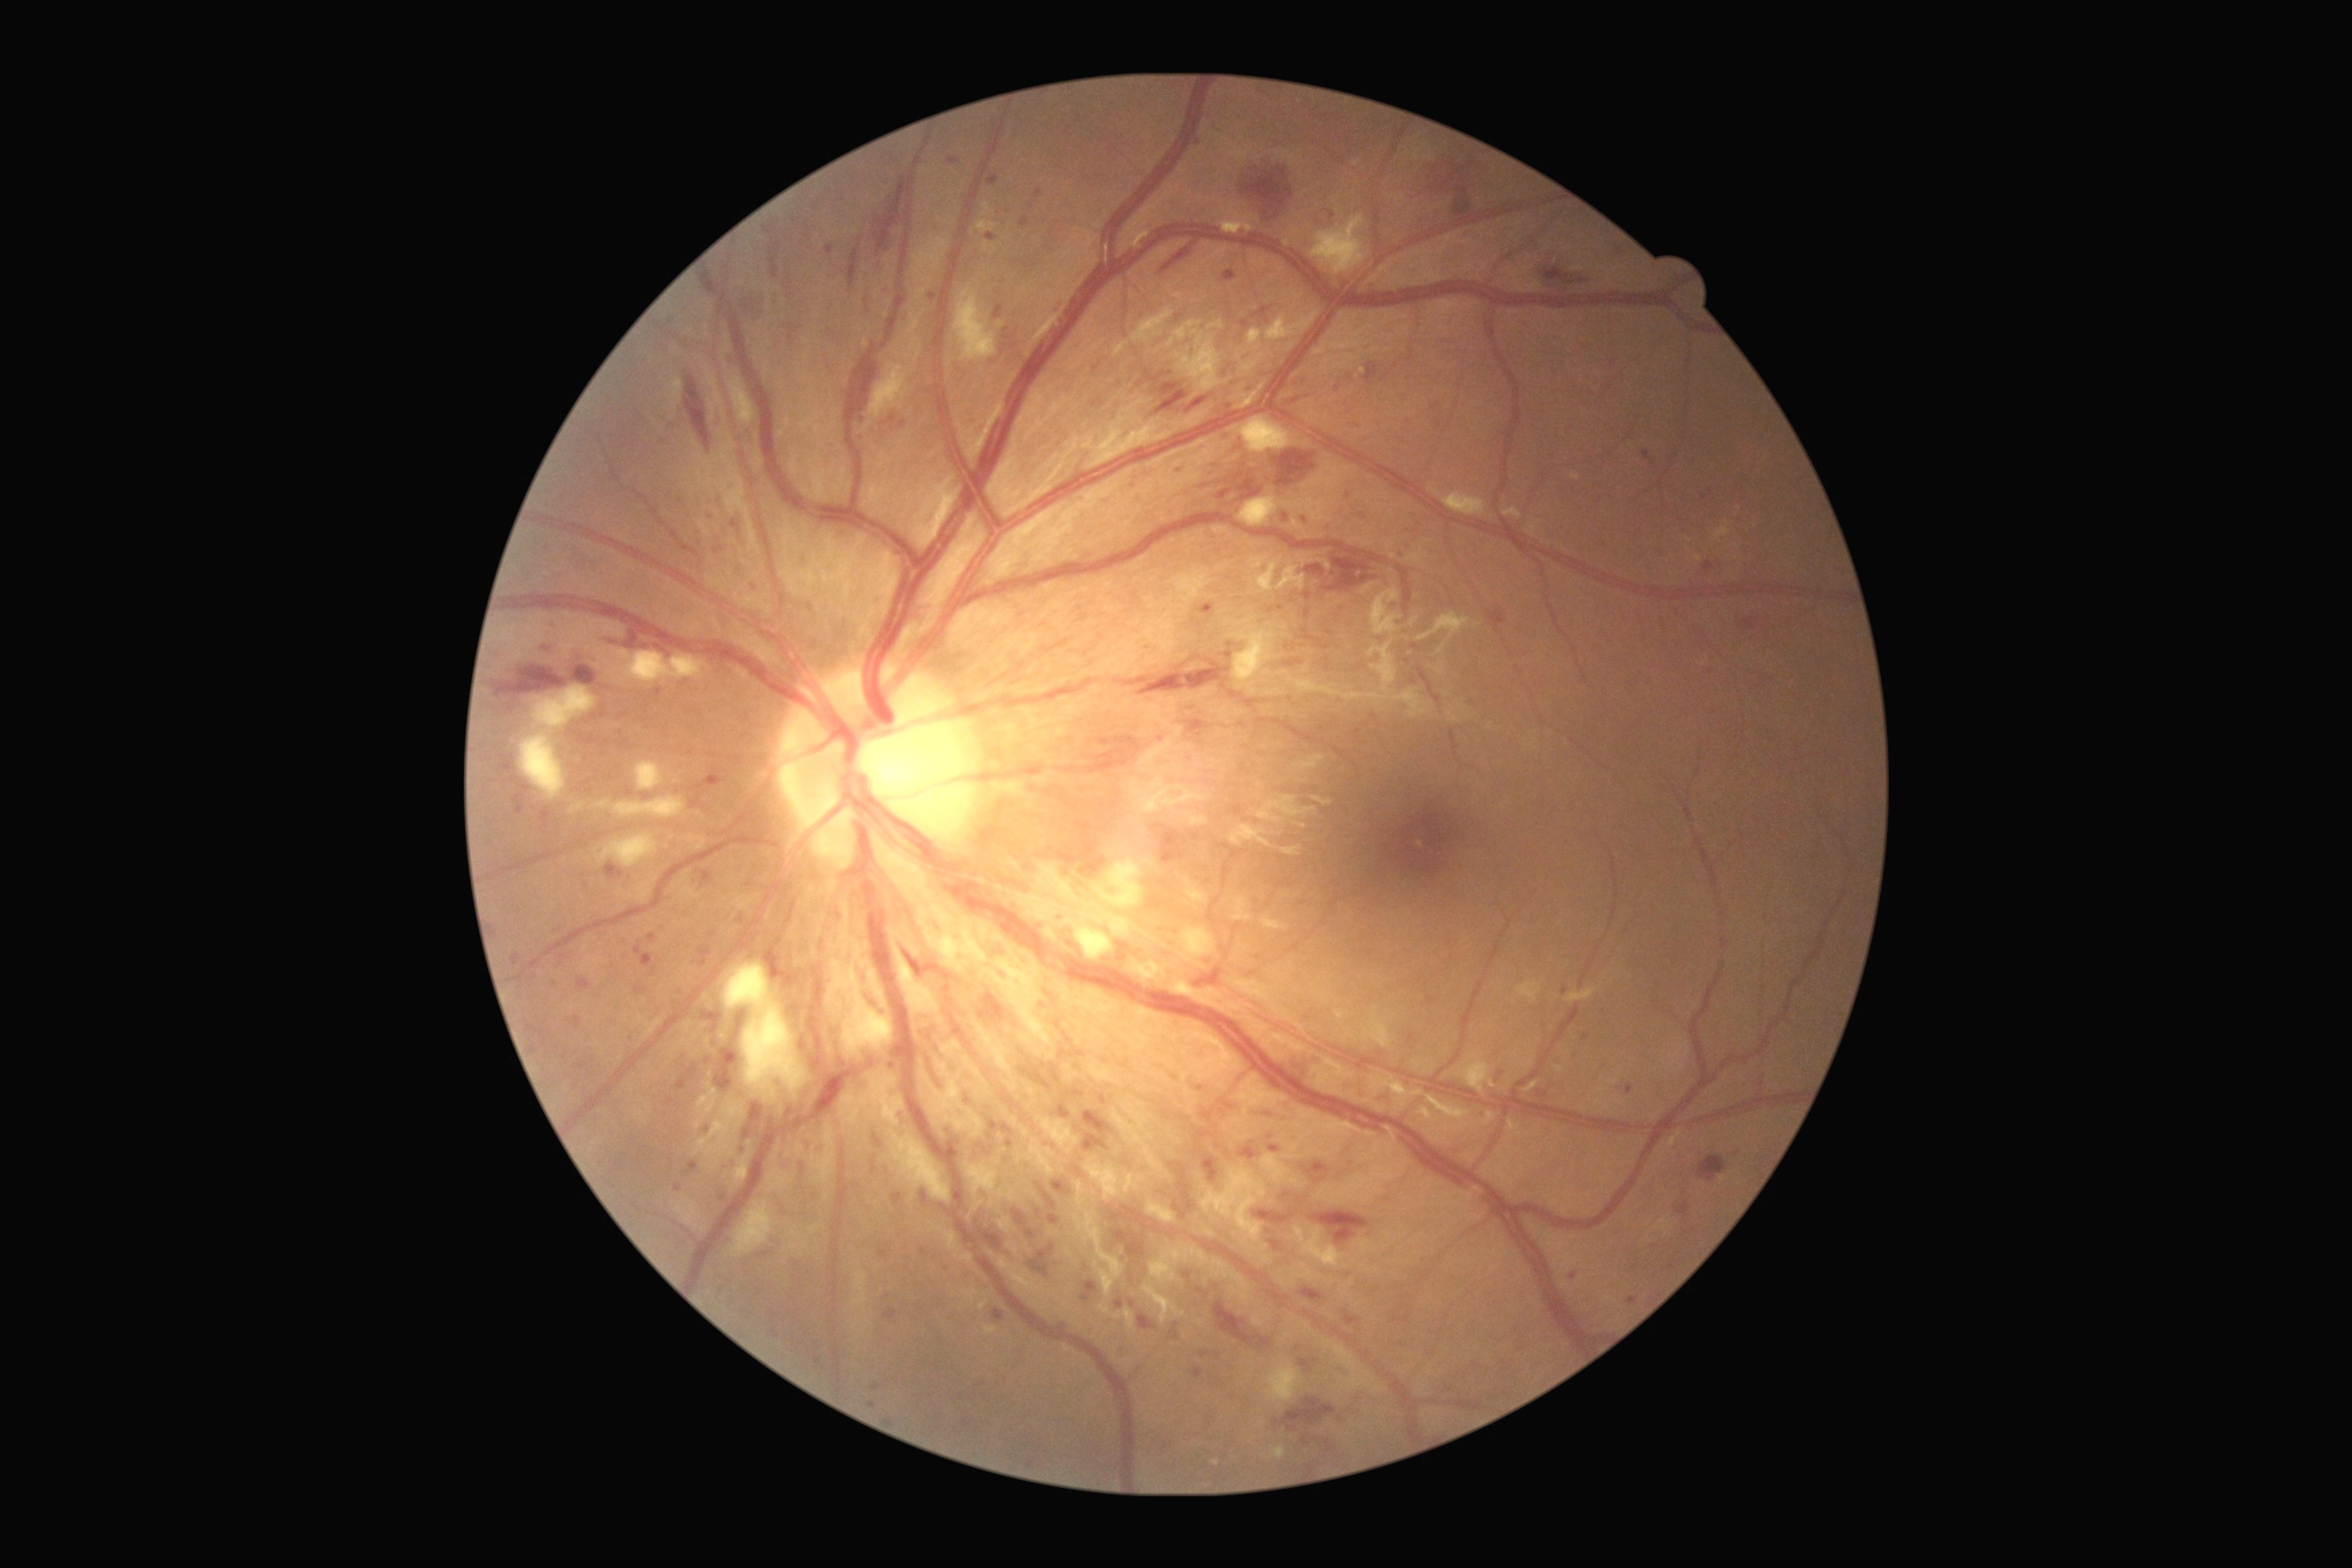

Diabetic retinopathy grade: 3.
Microaneurysms include those at BBox(1627, 1297, 1638, 1304) | BBox(1184, 1271, 1191, 1280) | BBox(678, 1068, 696, 1092) | BBox(1139, 1315, 1157, 1331) | BBox(892, 1193, 903, 1206) | BBox(1006, 1141, 1014, 1148) | BBox(921, 1190, 928, 1206) | BBox(801, 1164, 805, 1173) | BBox(654, 691, 662, 696) | BBox(1026, 1230, 1035, 1239) | BBox(1115, 1230, 1128, 1244) | BBox(636, 986, 647, 995).
Smaller microaneurysms around {"x": 863, "y": 420} | {"x": 1414, "y": 682} | {"x": 534, "y": 1049} | {"x": 1178, "y": 468} | {"x": 1227, "y": 437} | {"x": 1409, "y": 549} | {"x": 986, "y": 1150}.